2048 by 1536 pixels, color fundus image, 45° FOV.
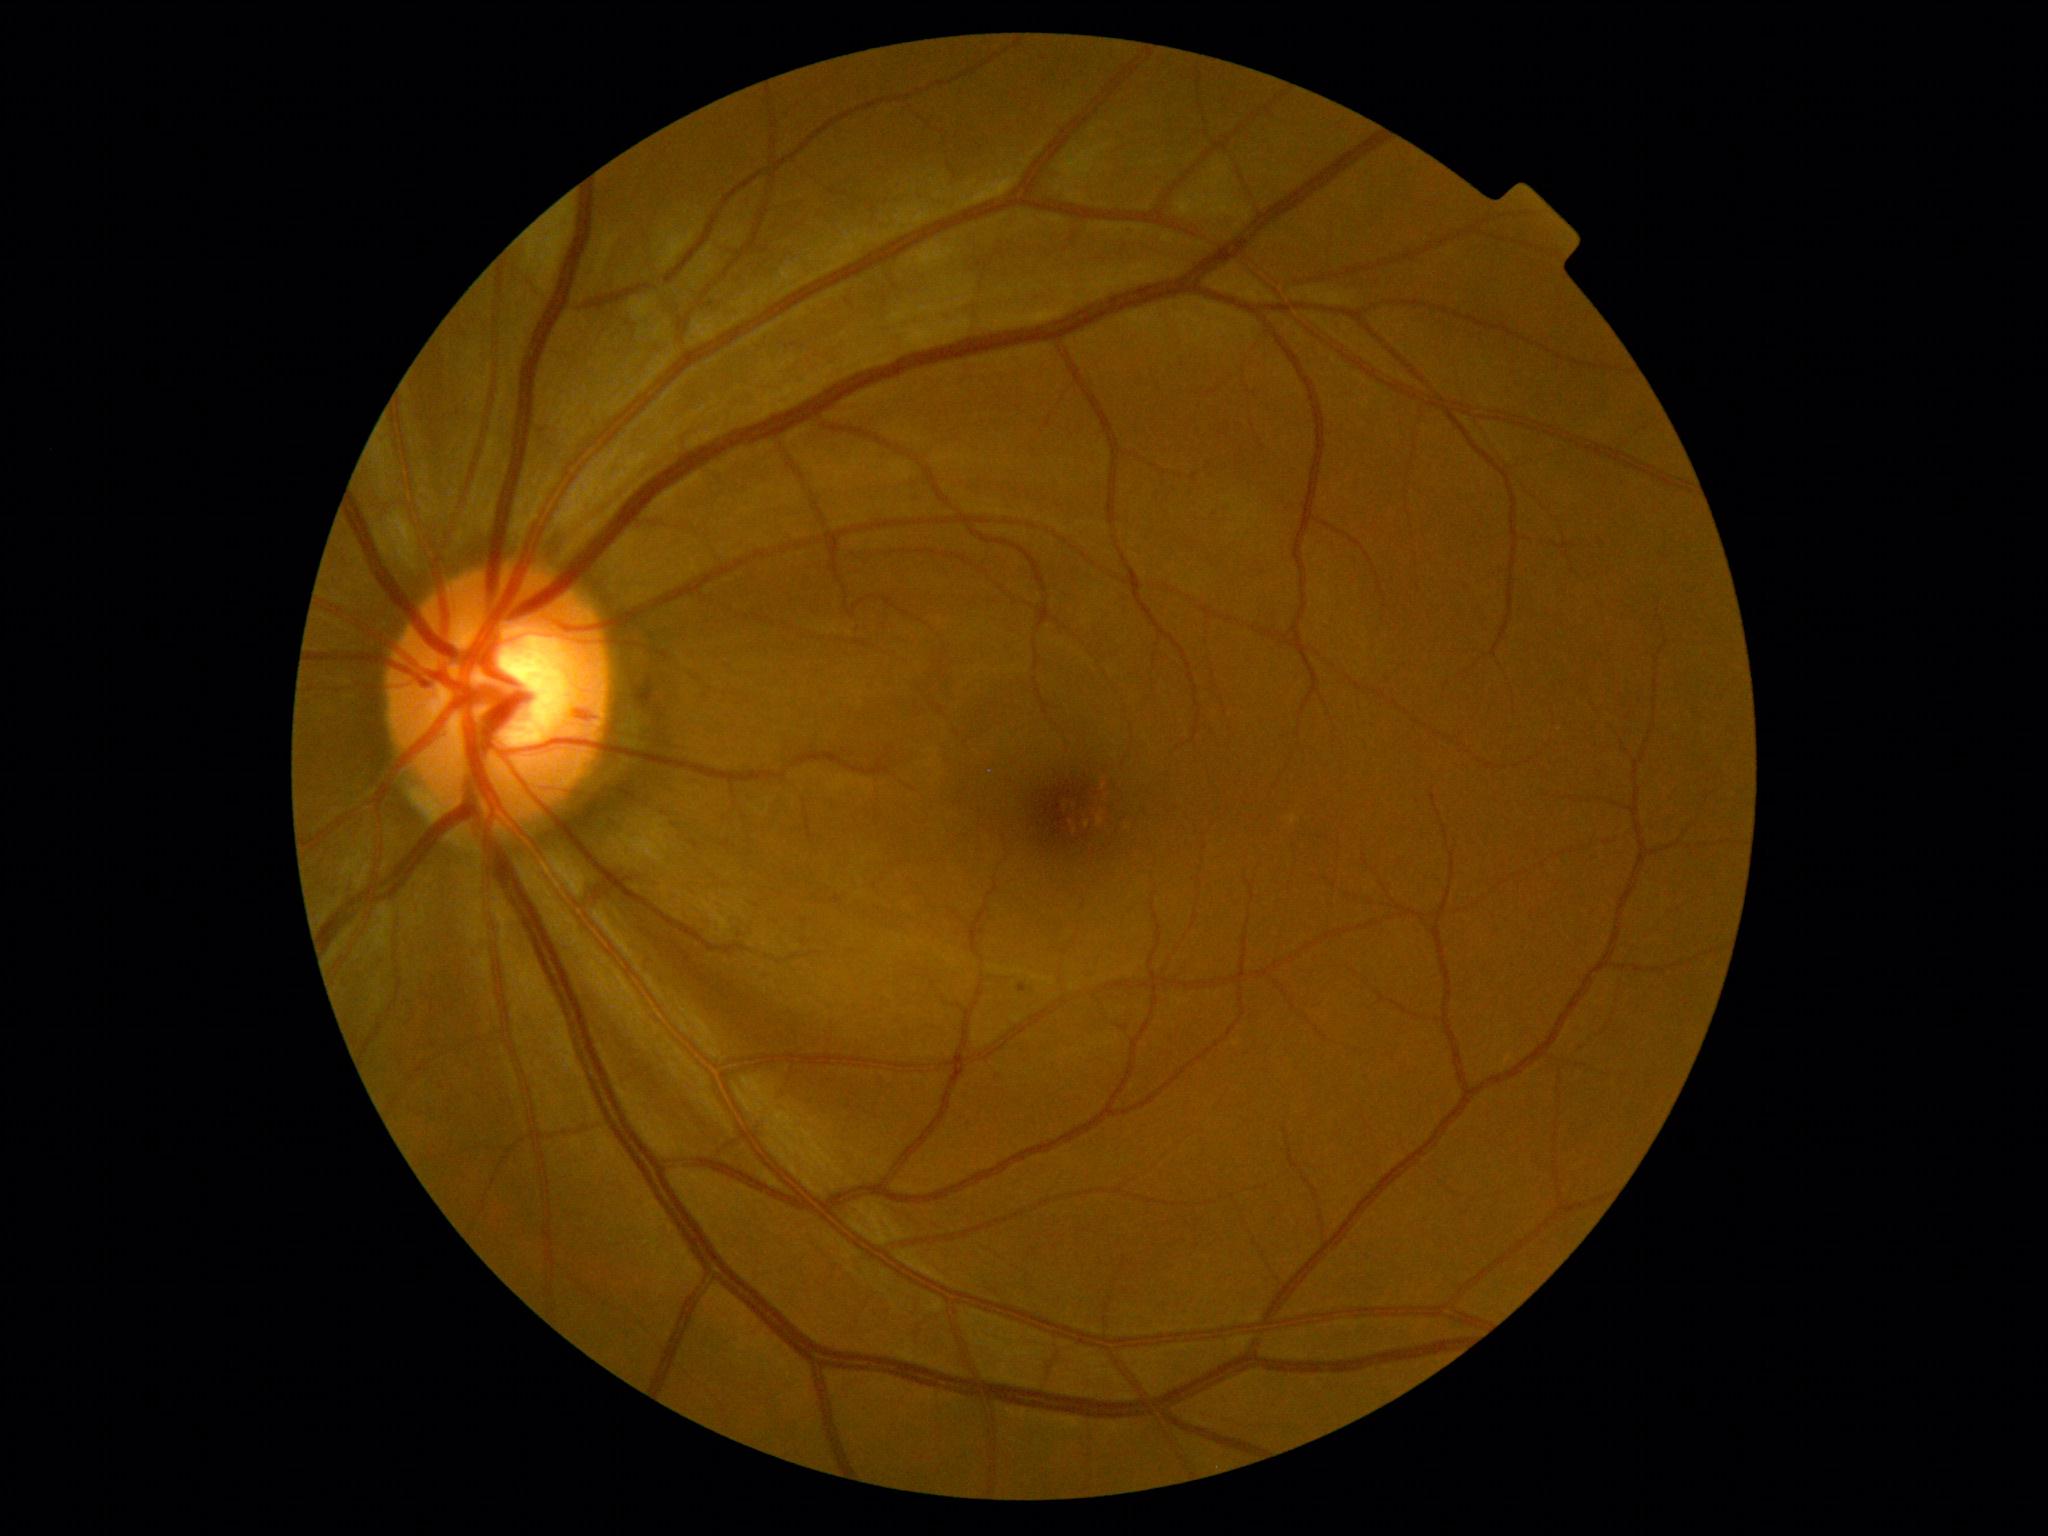

* DR grade — 1